Fundus photo.
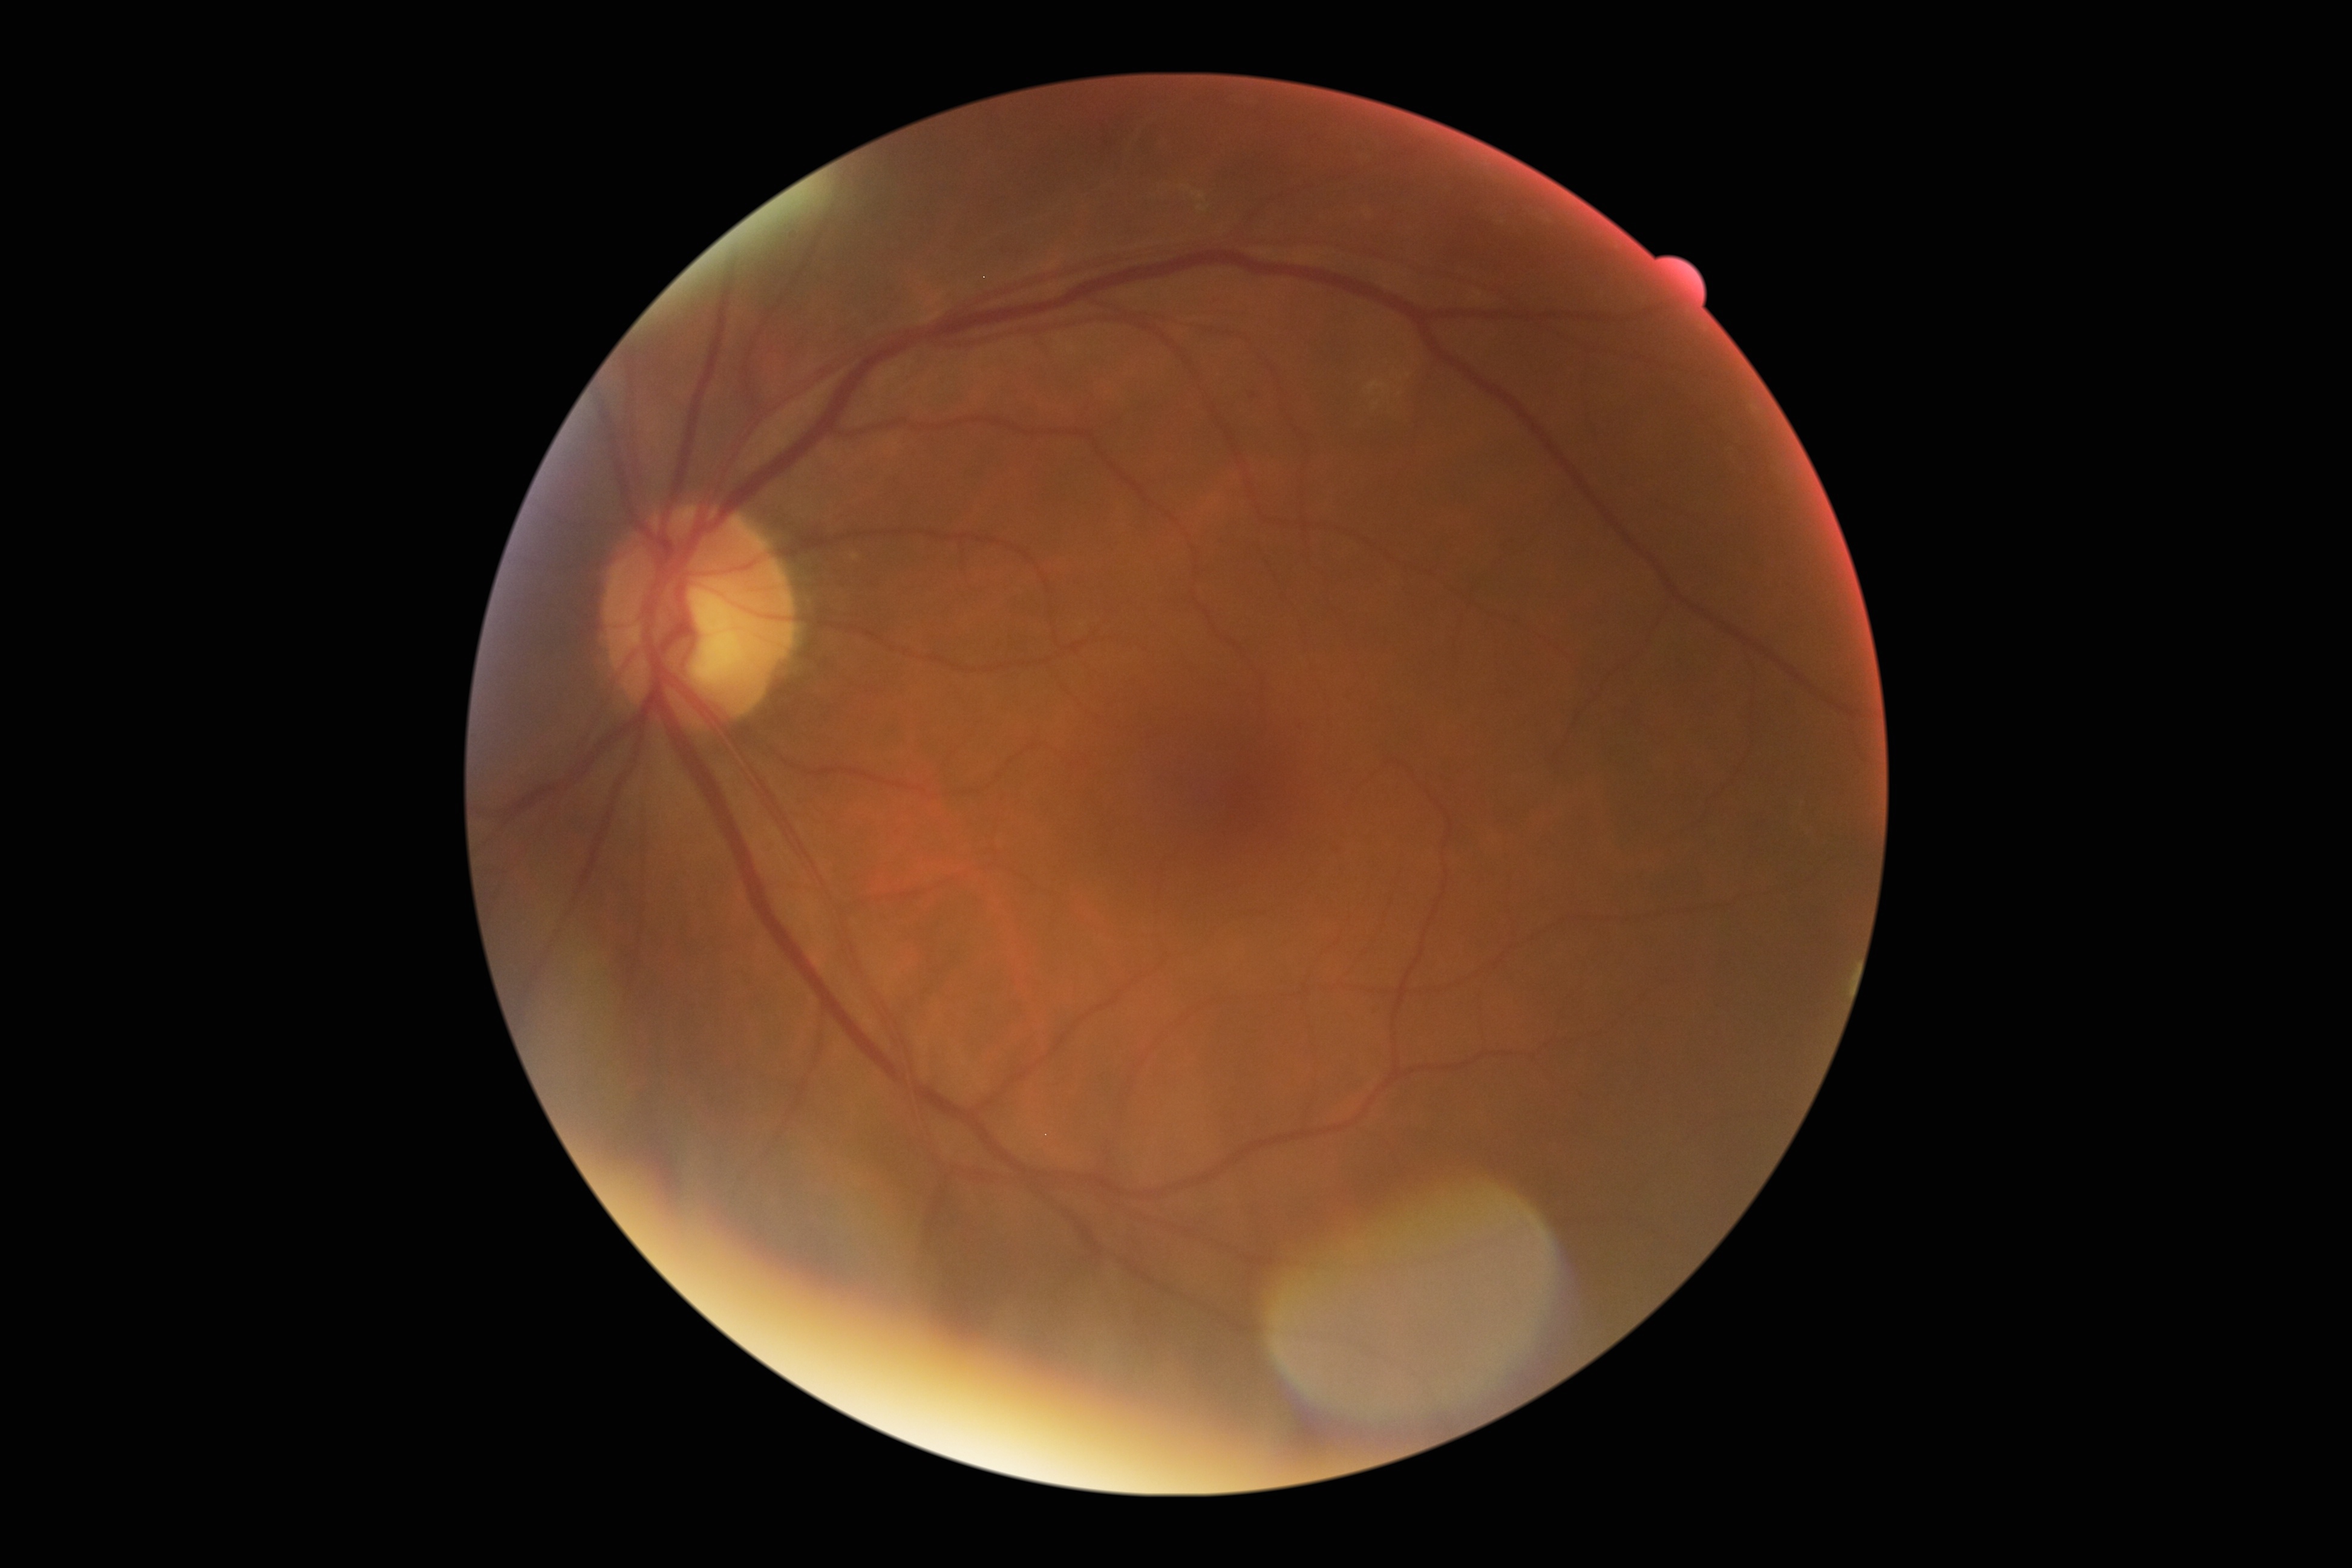 Diabetic retinopathy (DR) is grade 2.